Retinal fundus photograph · 1659 by 2212 pixels: 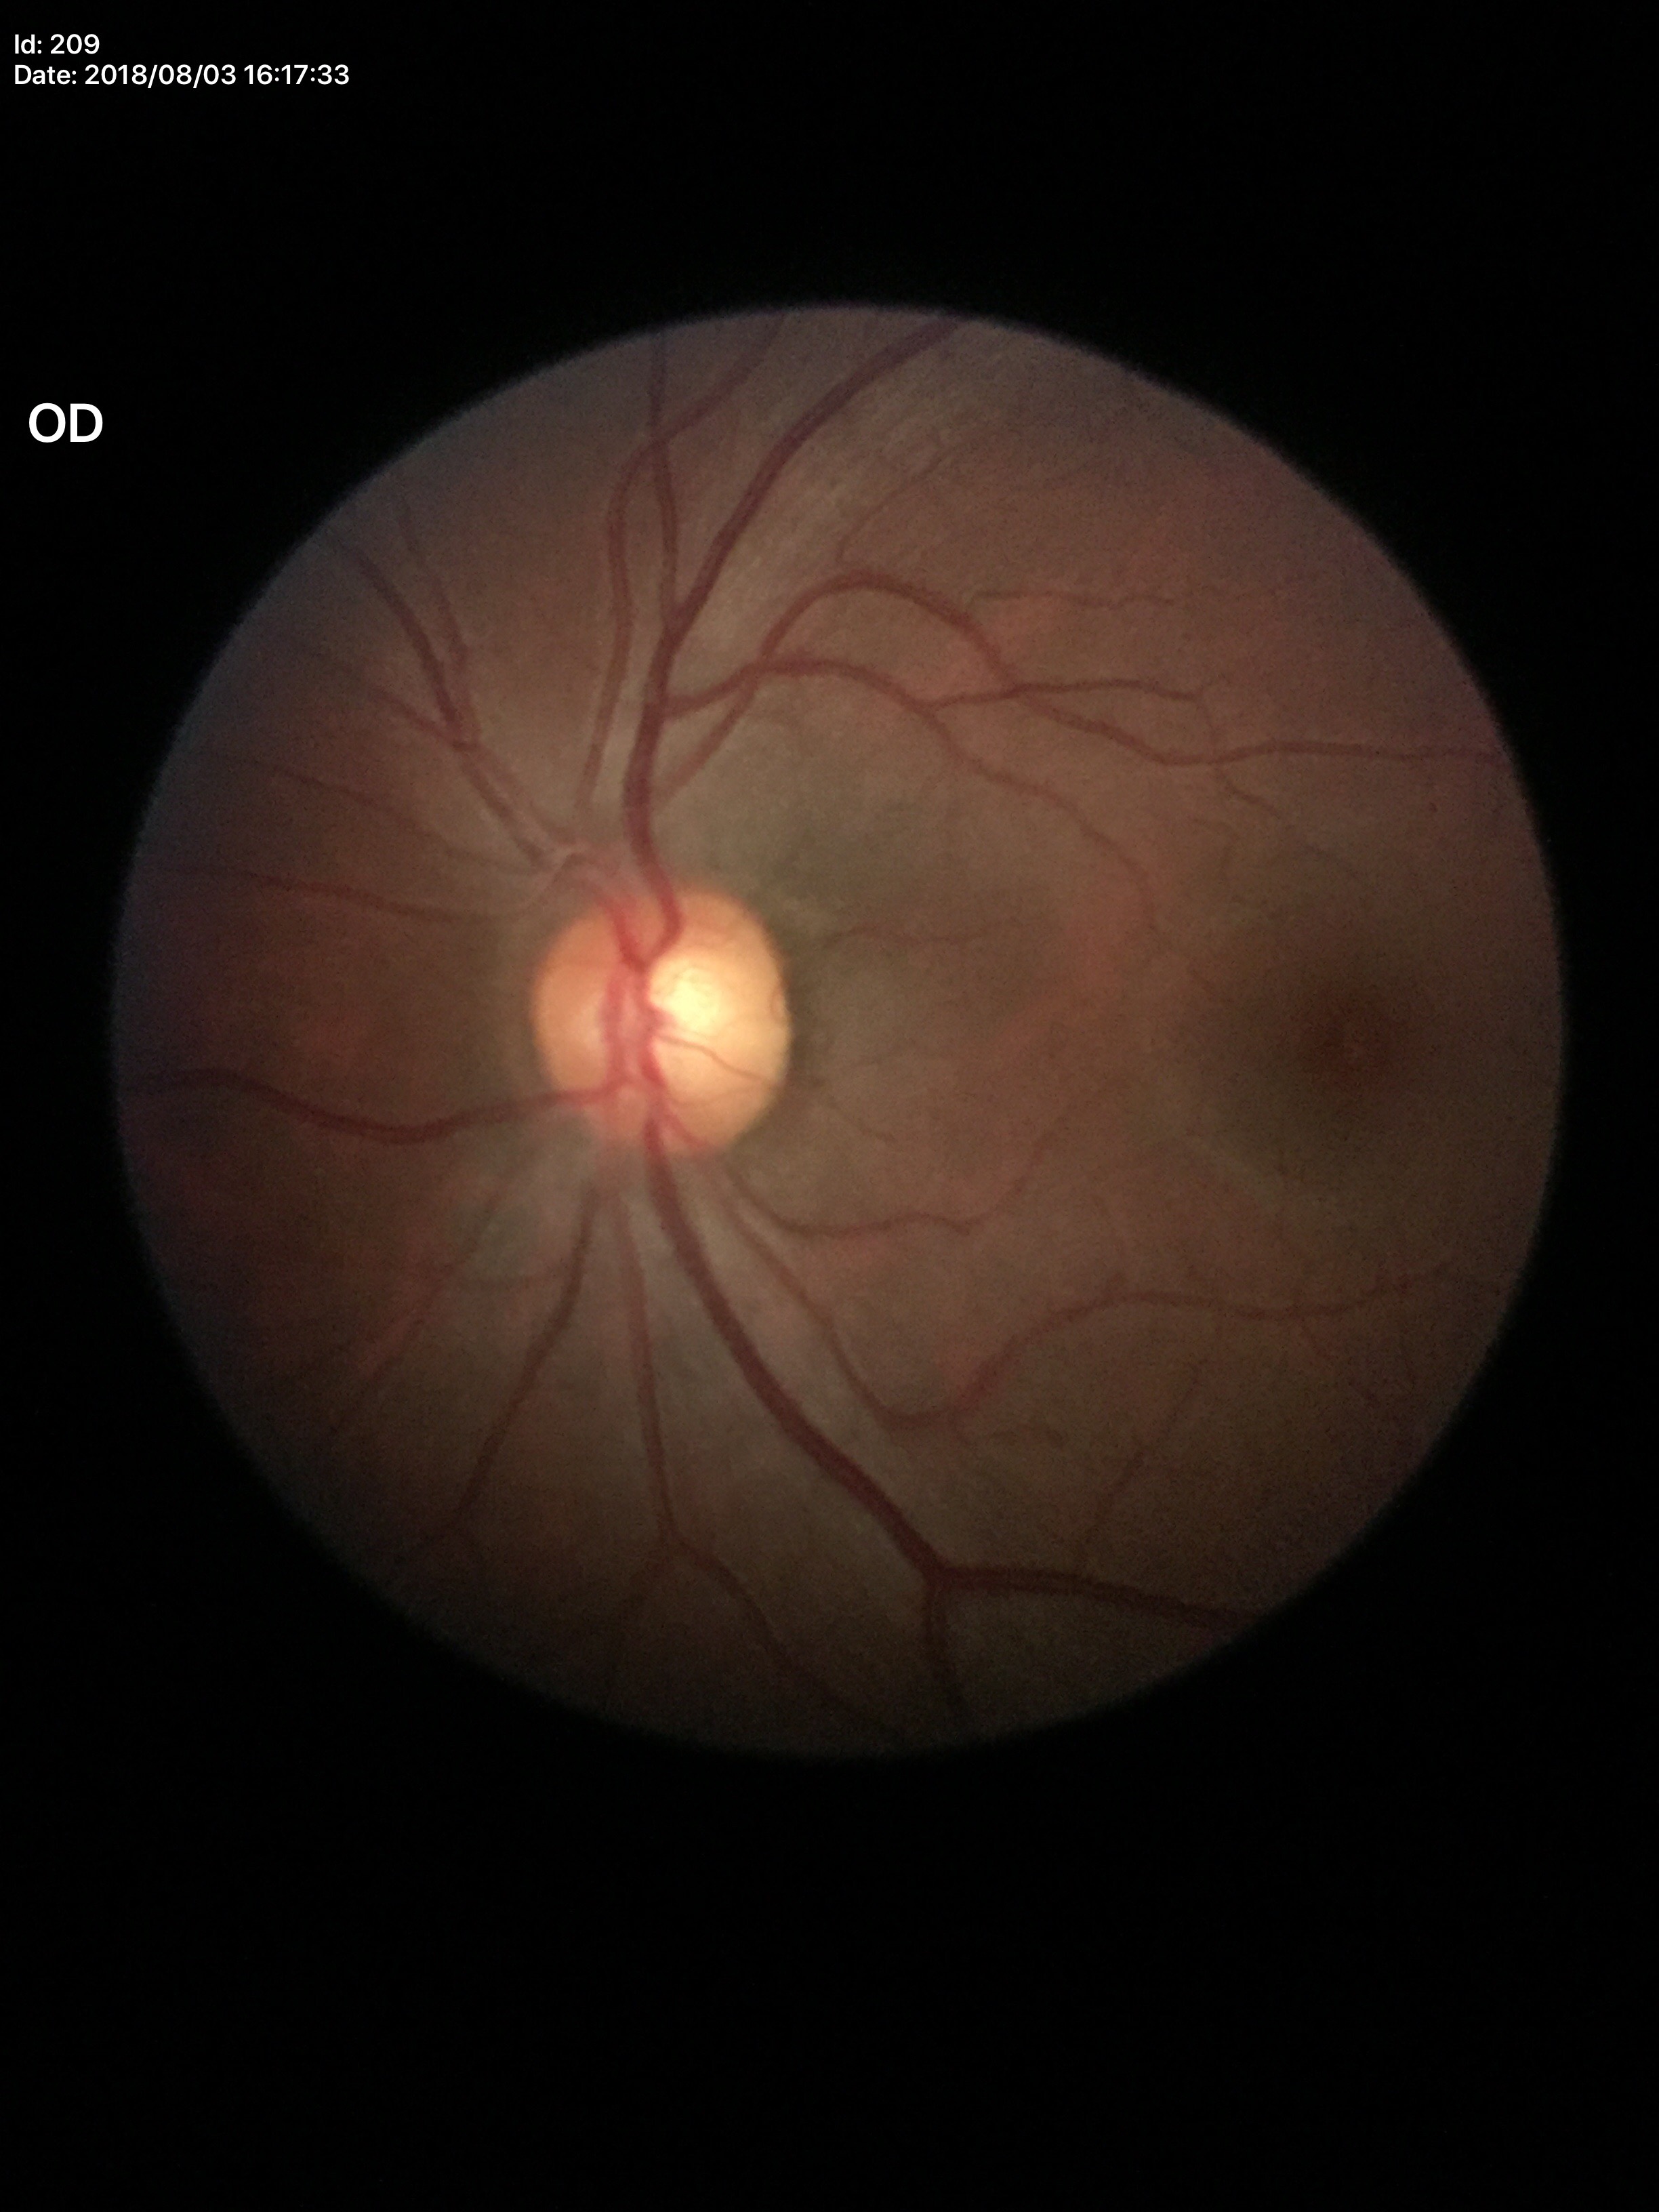 Q: Glaucoma screening result?
A: no suspicious findings (1/5 graders called glaucoma suspect)
Q: Vertical CDR?
A: 0.54